Dilated-pupil acquisition. Acquired with a Kowa VX-10α — 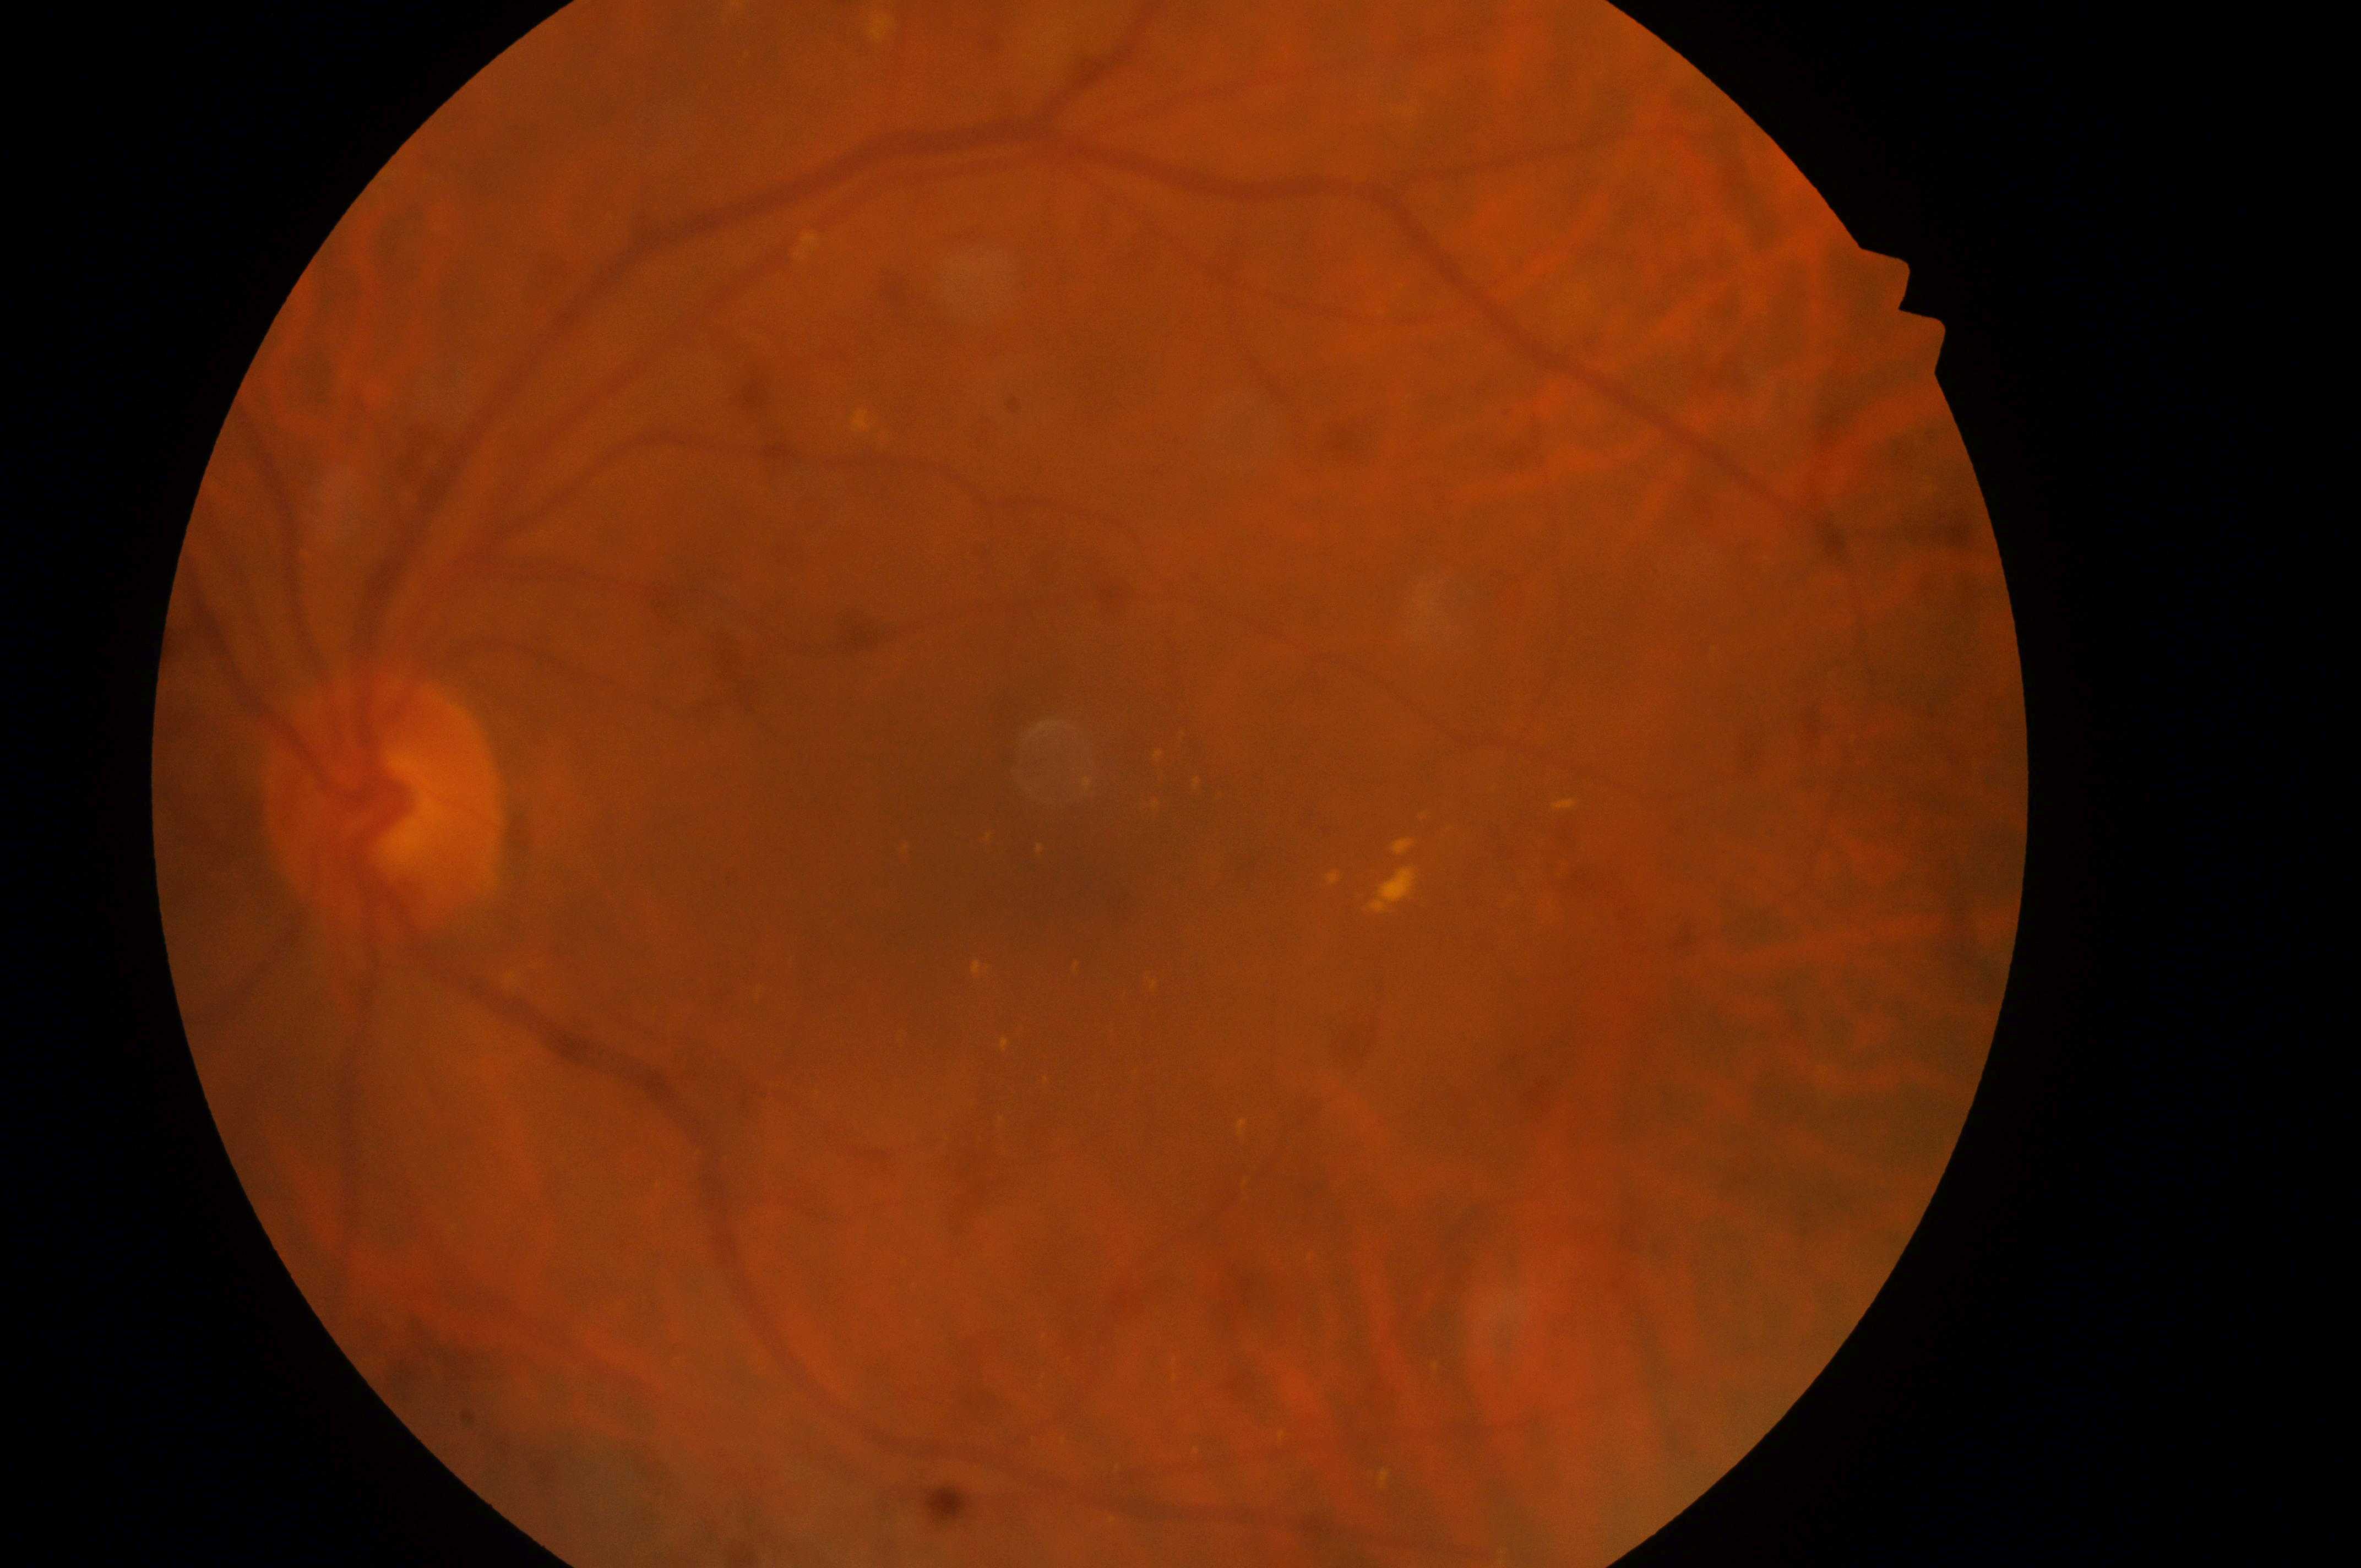

diabetic retinopathy (DR) = moderate non-proliferative diabetic retinopathy (grade 2); laterality = oculus sinister; macular center = (1085, 866); ONH = (373, 810); diabetic macular edema (DME) = high risk (grade 2); DR class = non-proliferative diabetic retinopathy.